Pediatric wide-field fundus photograph; 640 by 480 pixels:
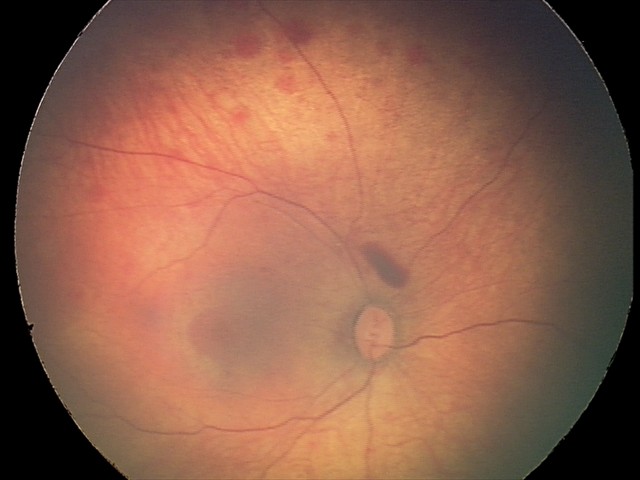
Examination diagnosed as retinal hemorrhages.